50° FOV · dilated-pupil acquisition · color fundus image · captured on a Topcon TRC-50DX fundus camera: 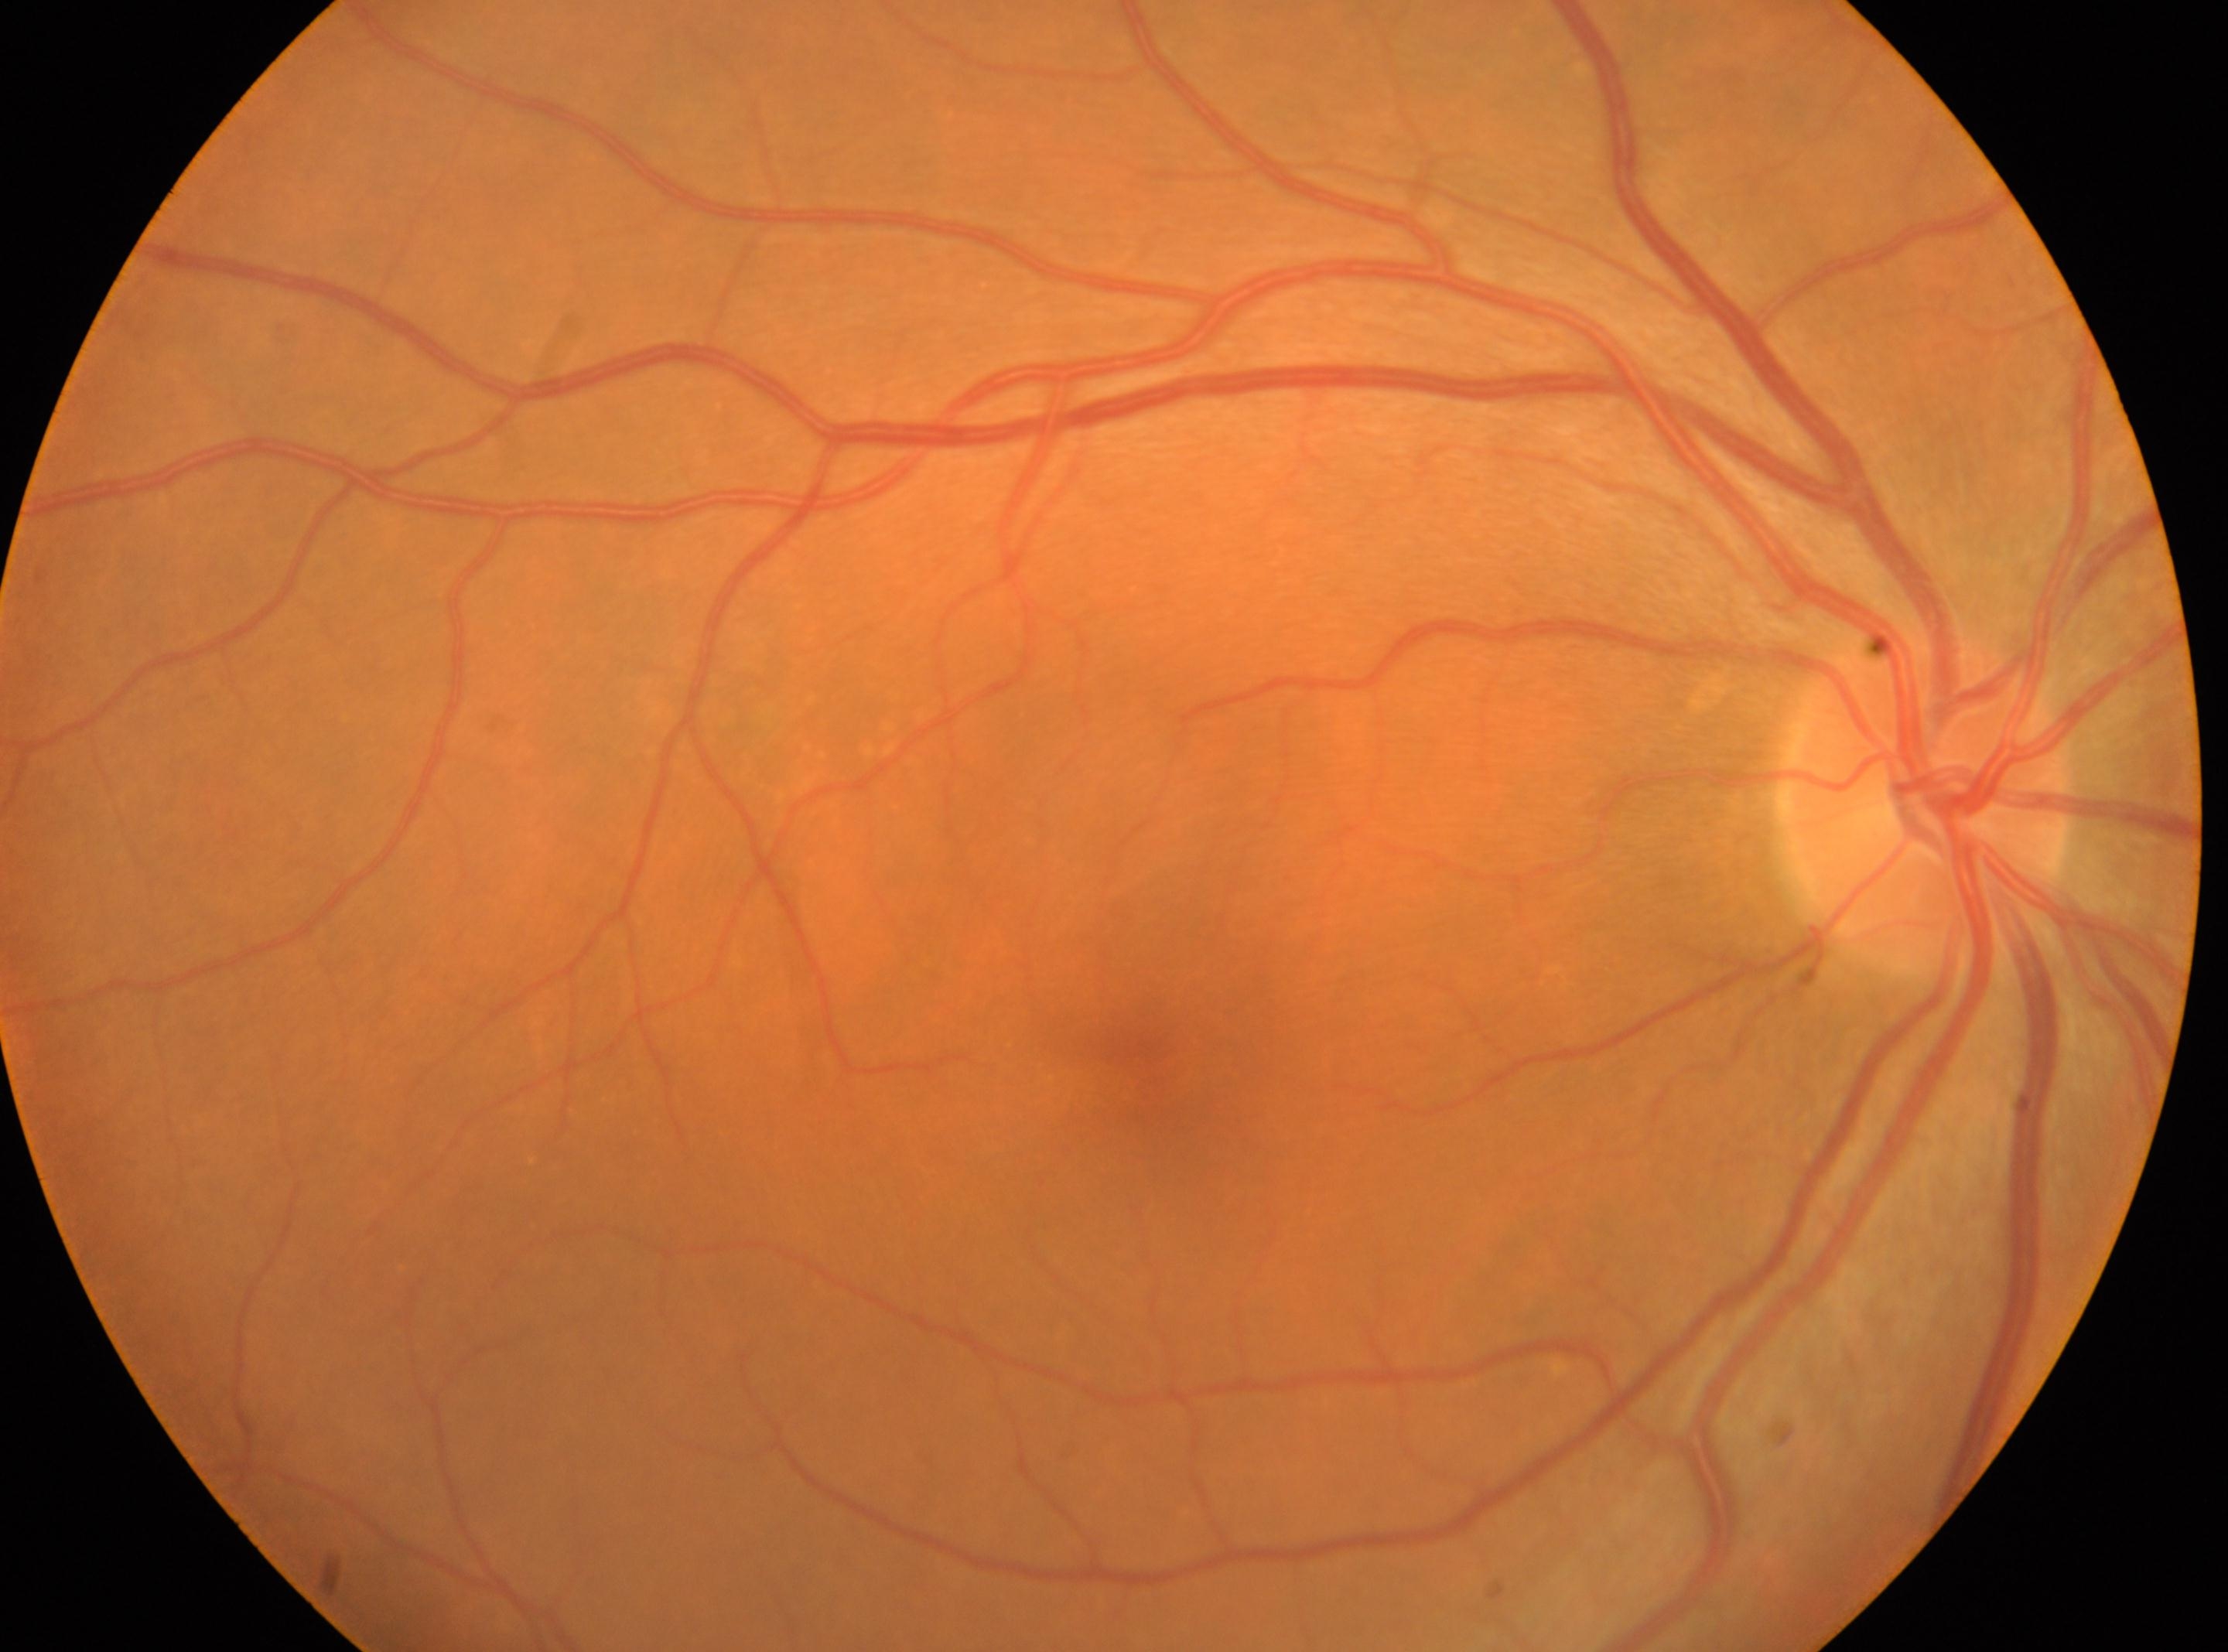

the optic disc = (x: 1928, y: 804), DR stage = grade 0 (no apparent retinopathy) — no visible signs of diabetic retinopathy, laterality = right, macular center = (x: 1150, y: 1049).